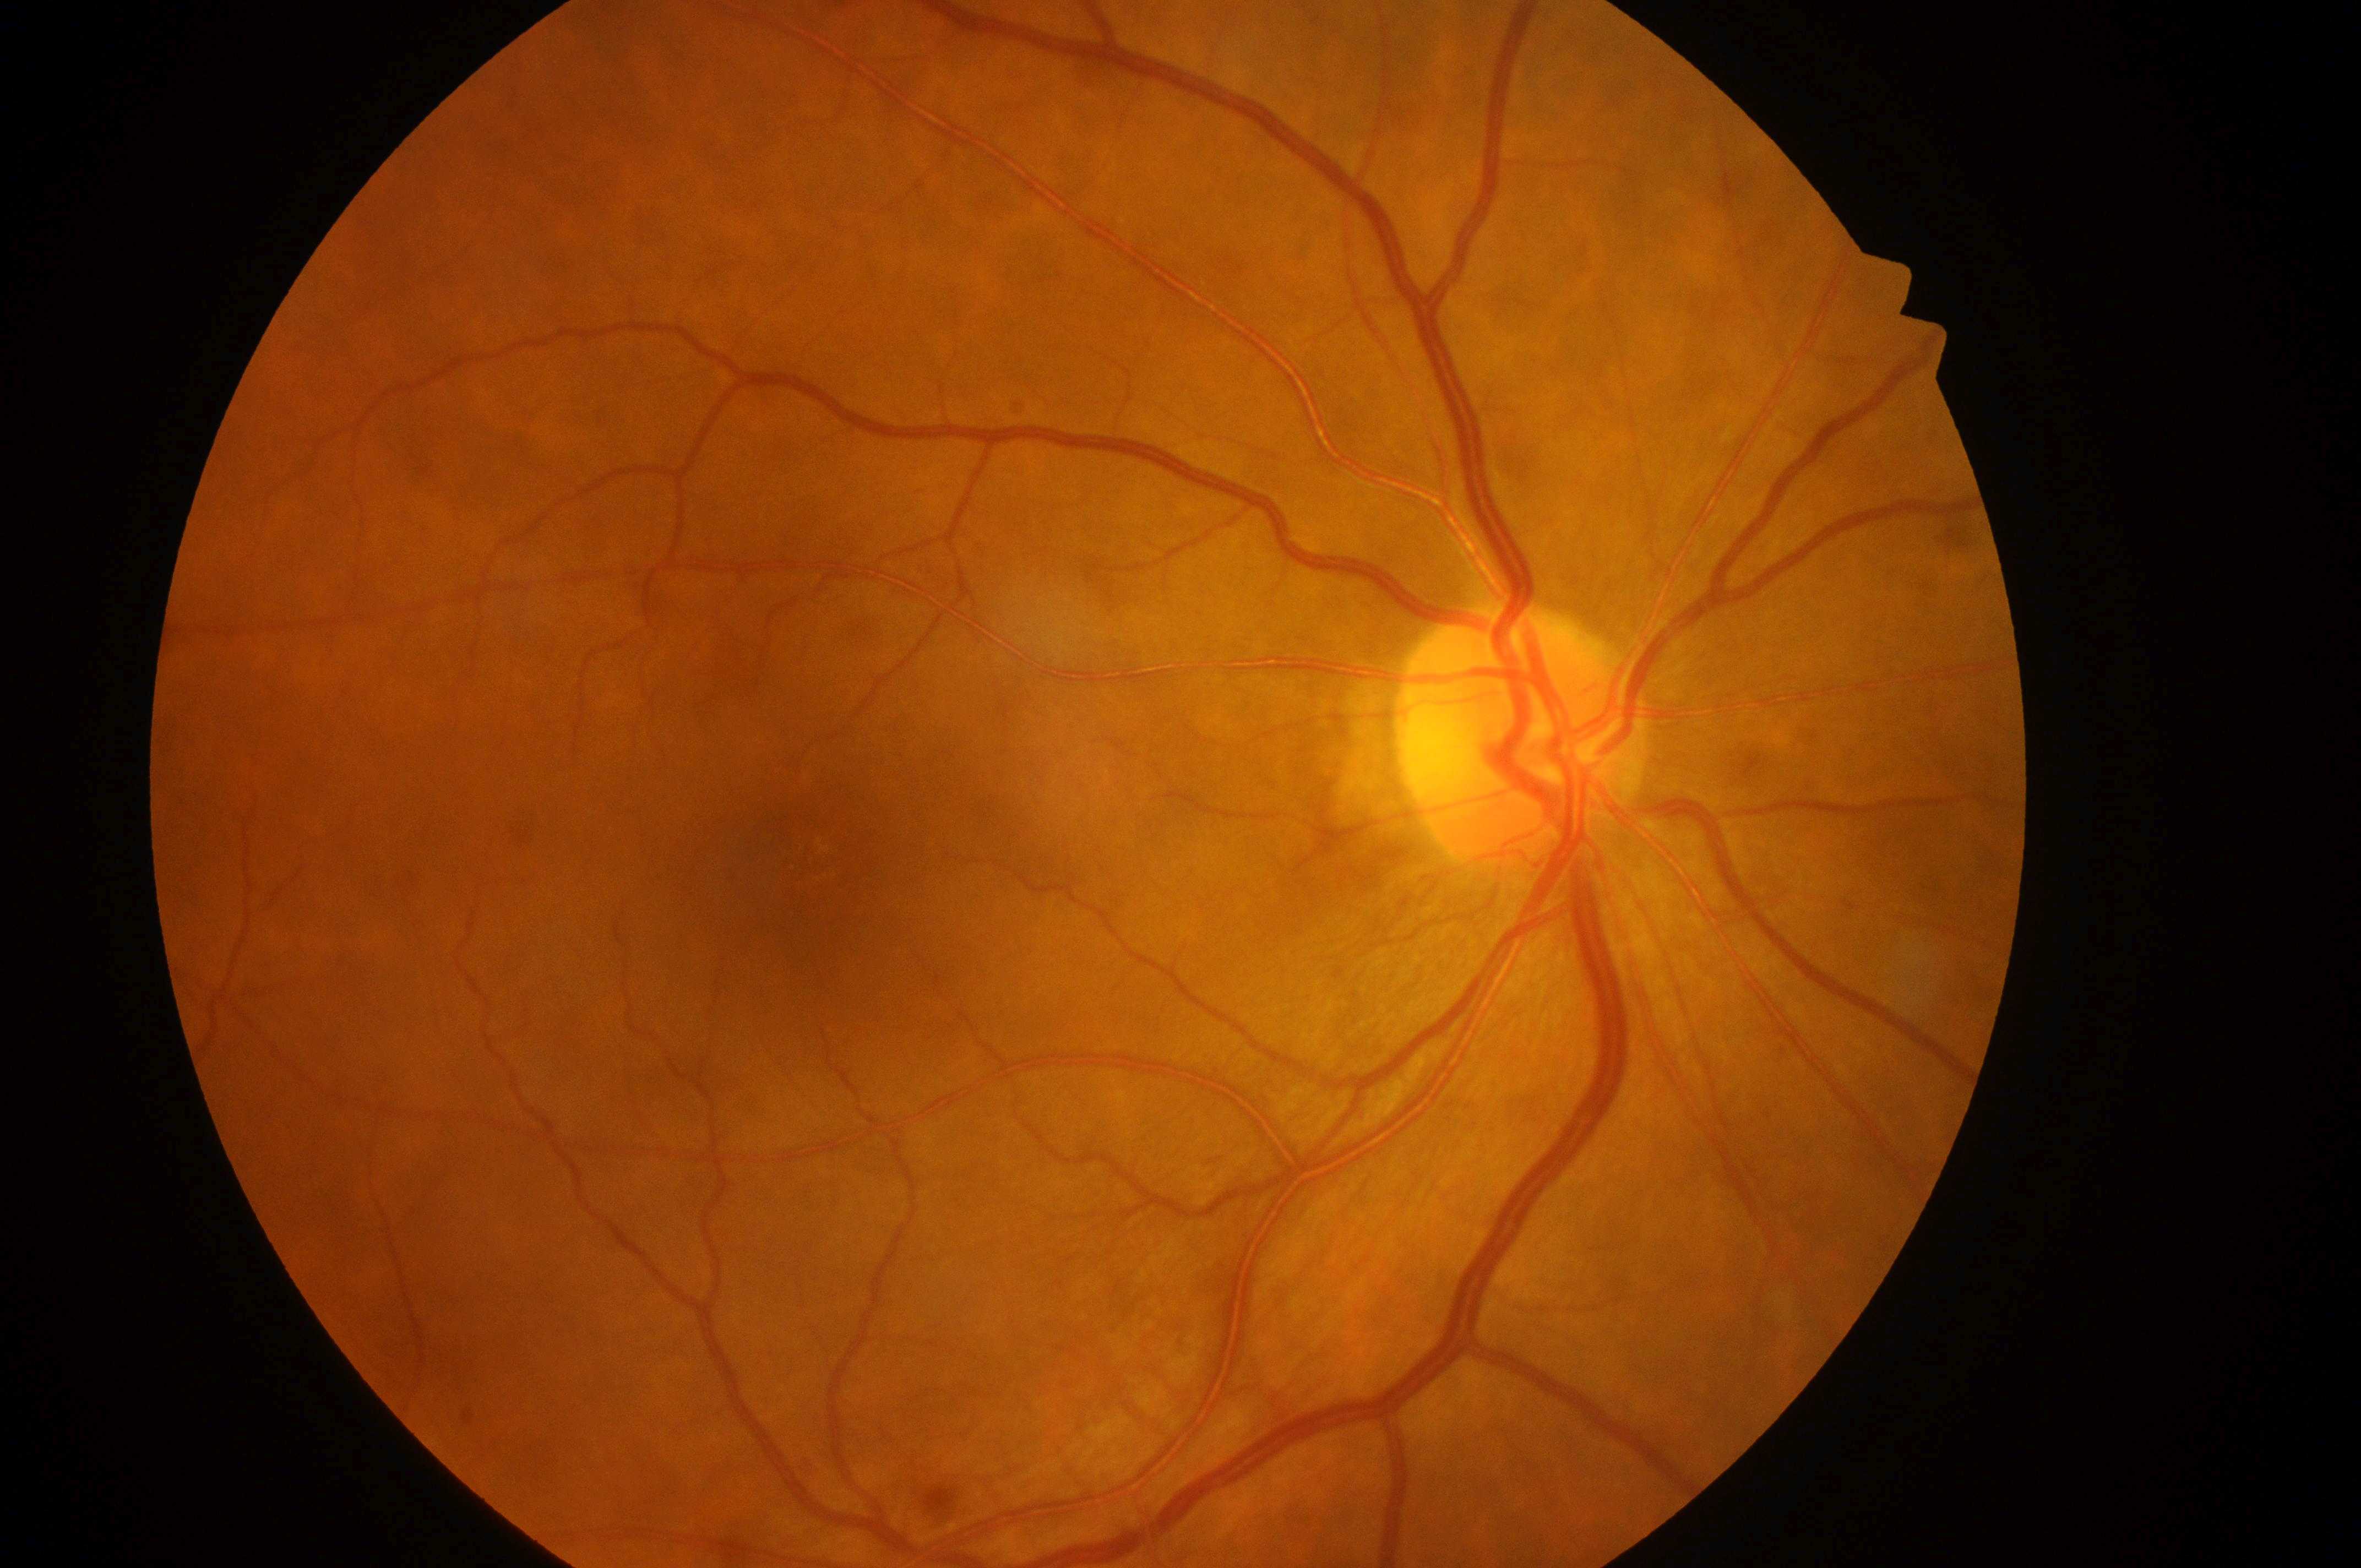 Fovea located at x=808, y=868. Optic disc located at x=1514, y=746. Diabetic retinopathy: severe non-proliferative diabetic retinopathy (grade 3). This is the right eye. Risk of macular edema: no risk (grade 0).